CFP — 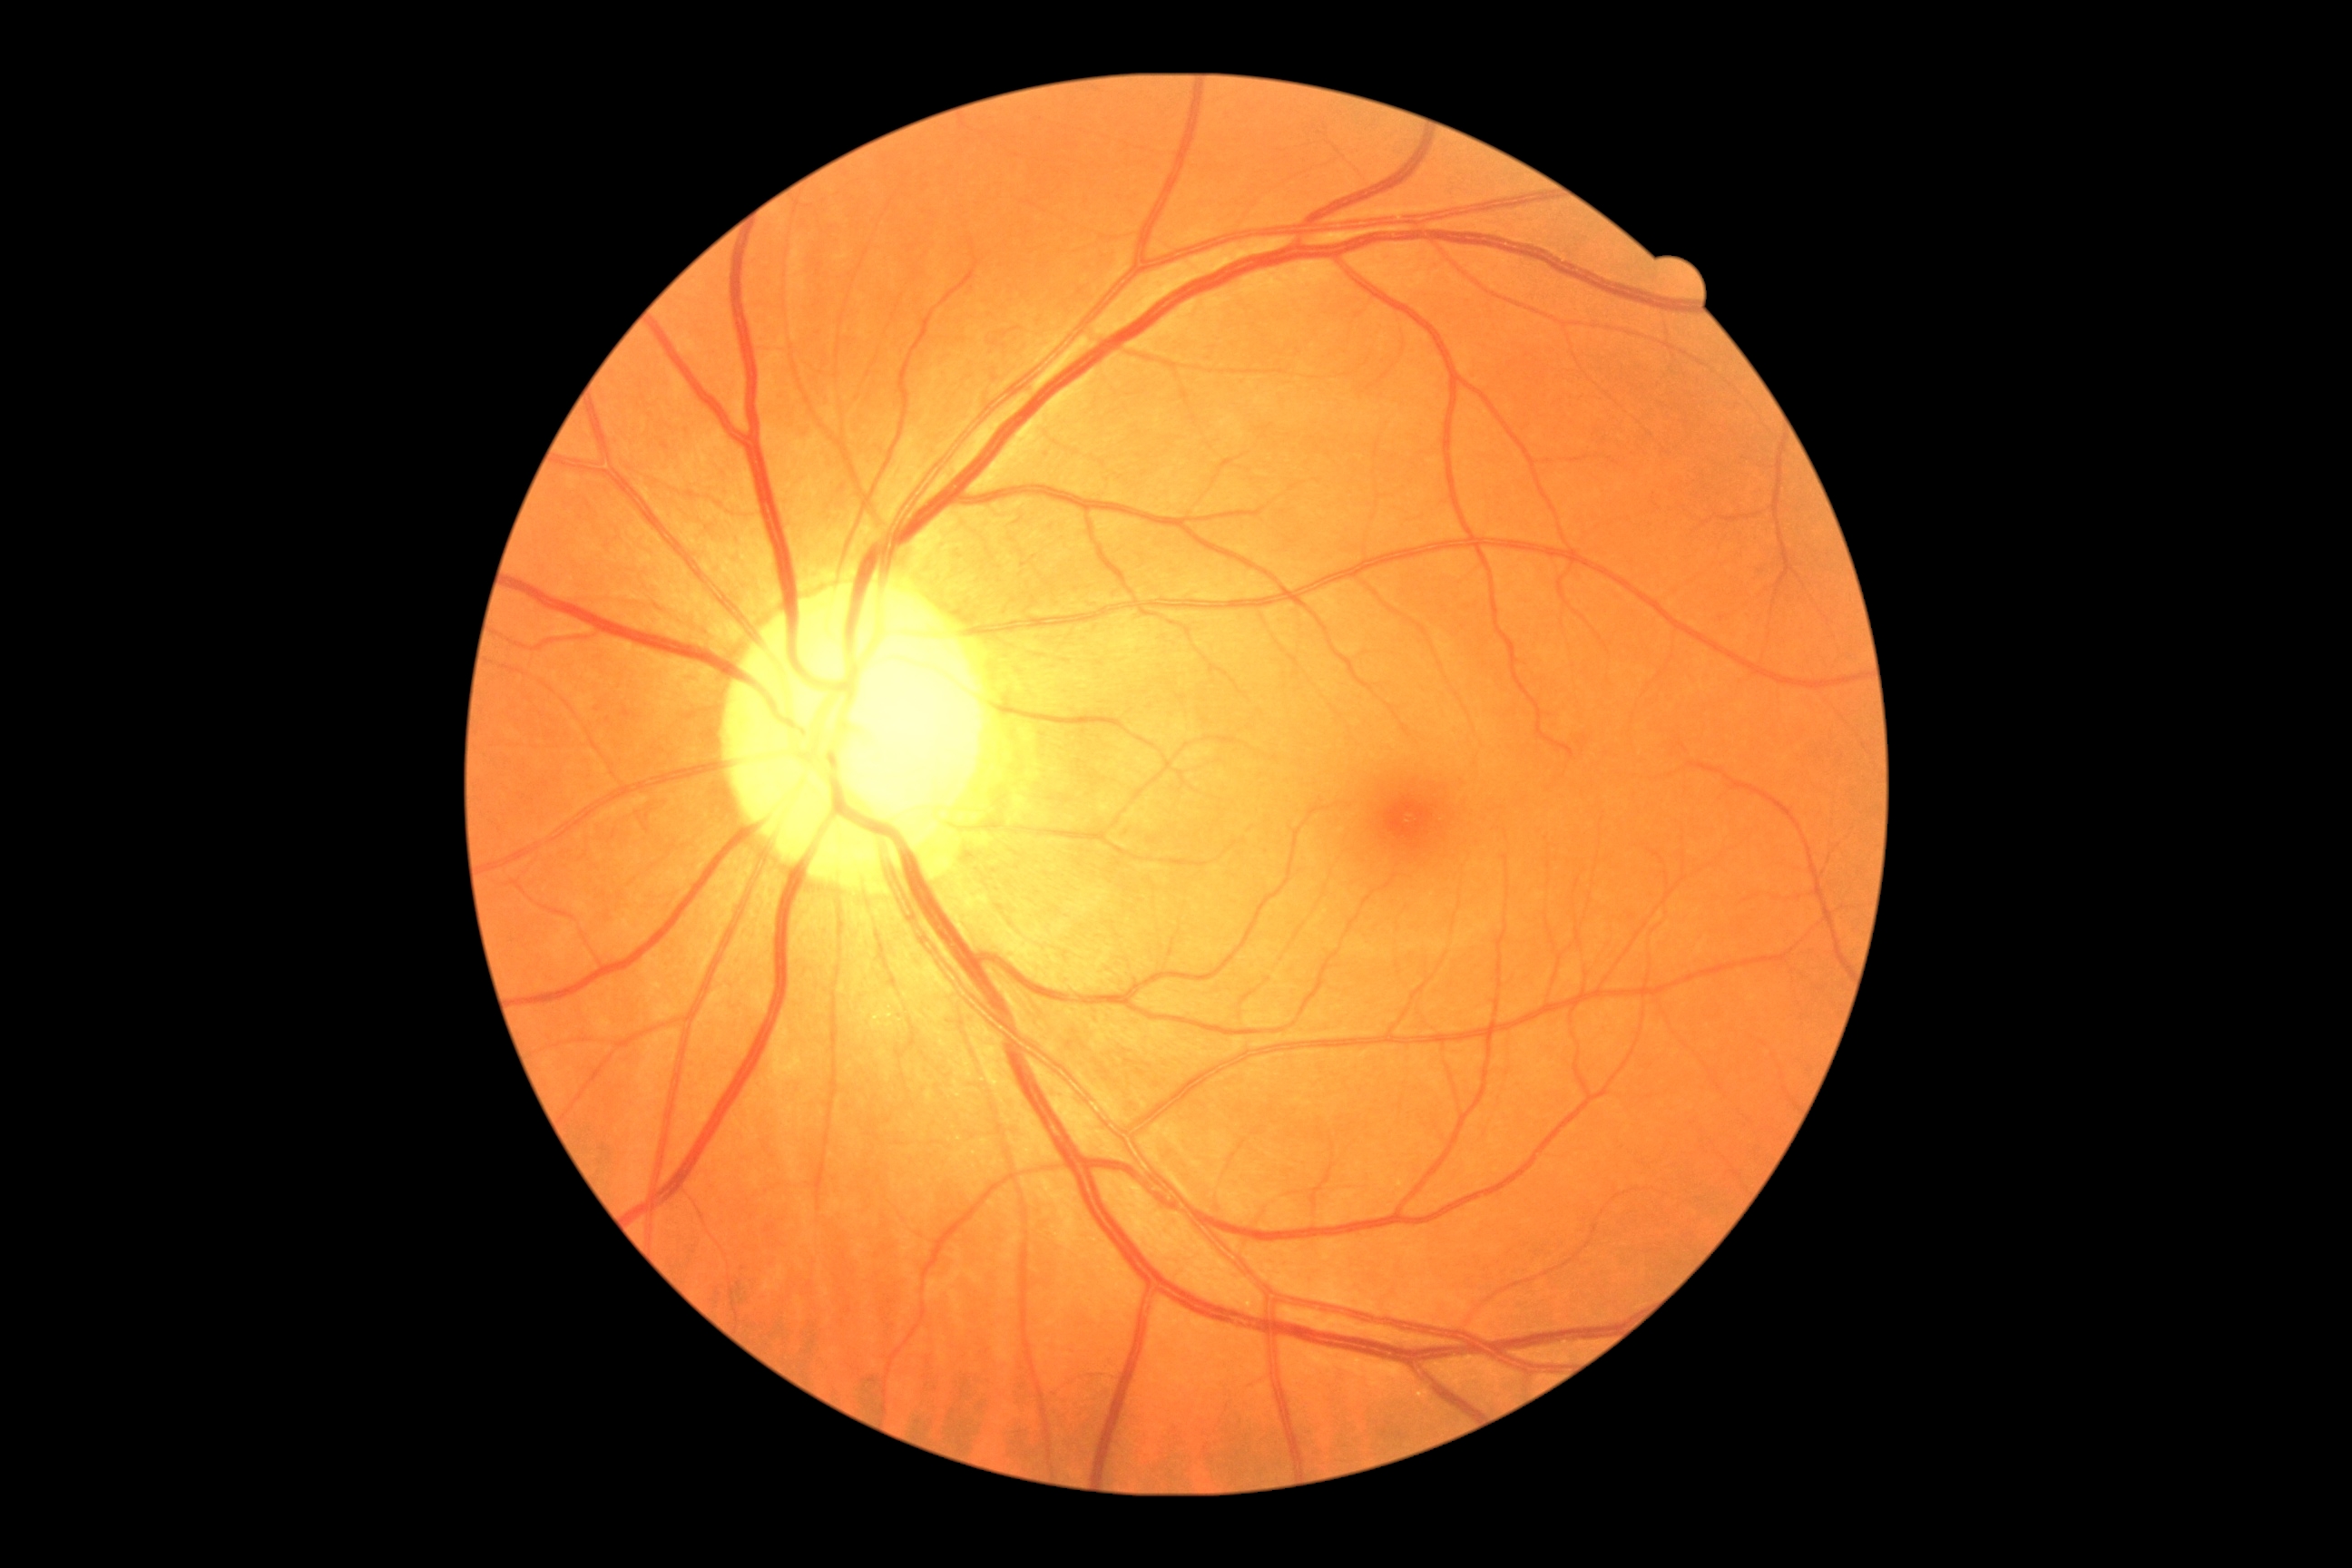
diabetic retinopathy: 0.